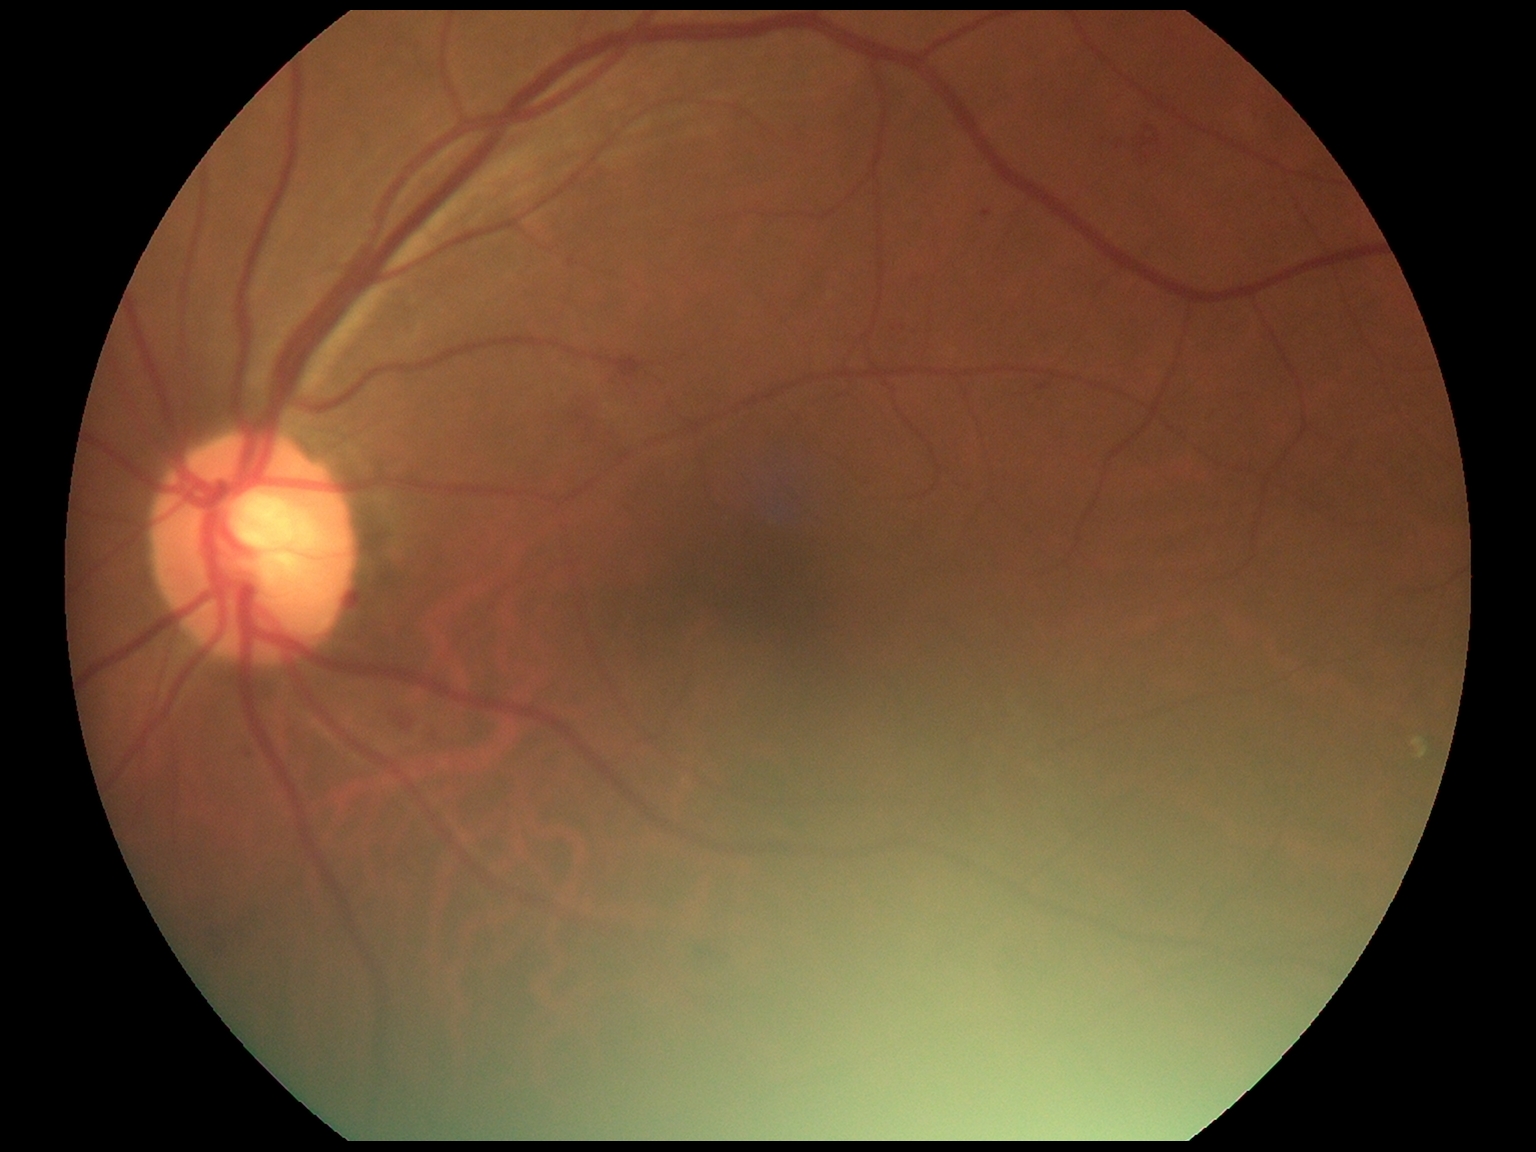
DR severity: moderate non-proliferative diabetic retinopathy (grade 2). Disease class: non-proliferative diabetic retinopathy.